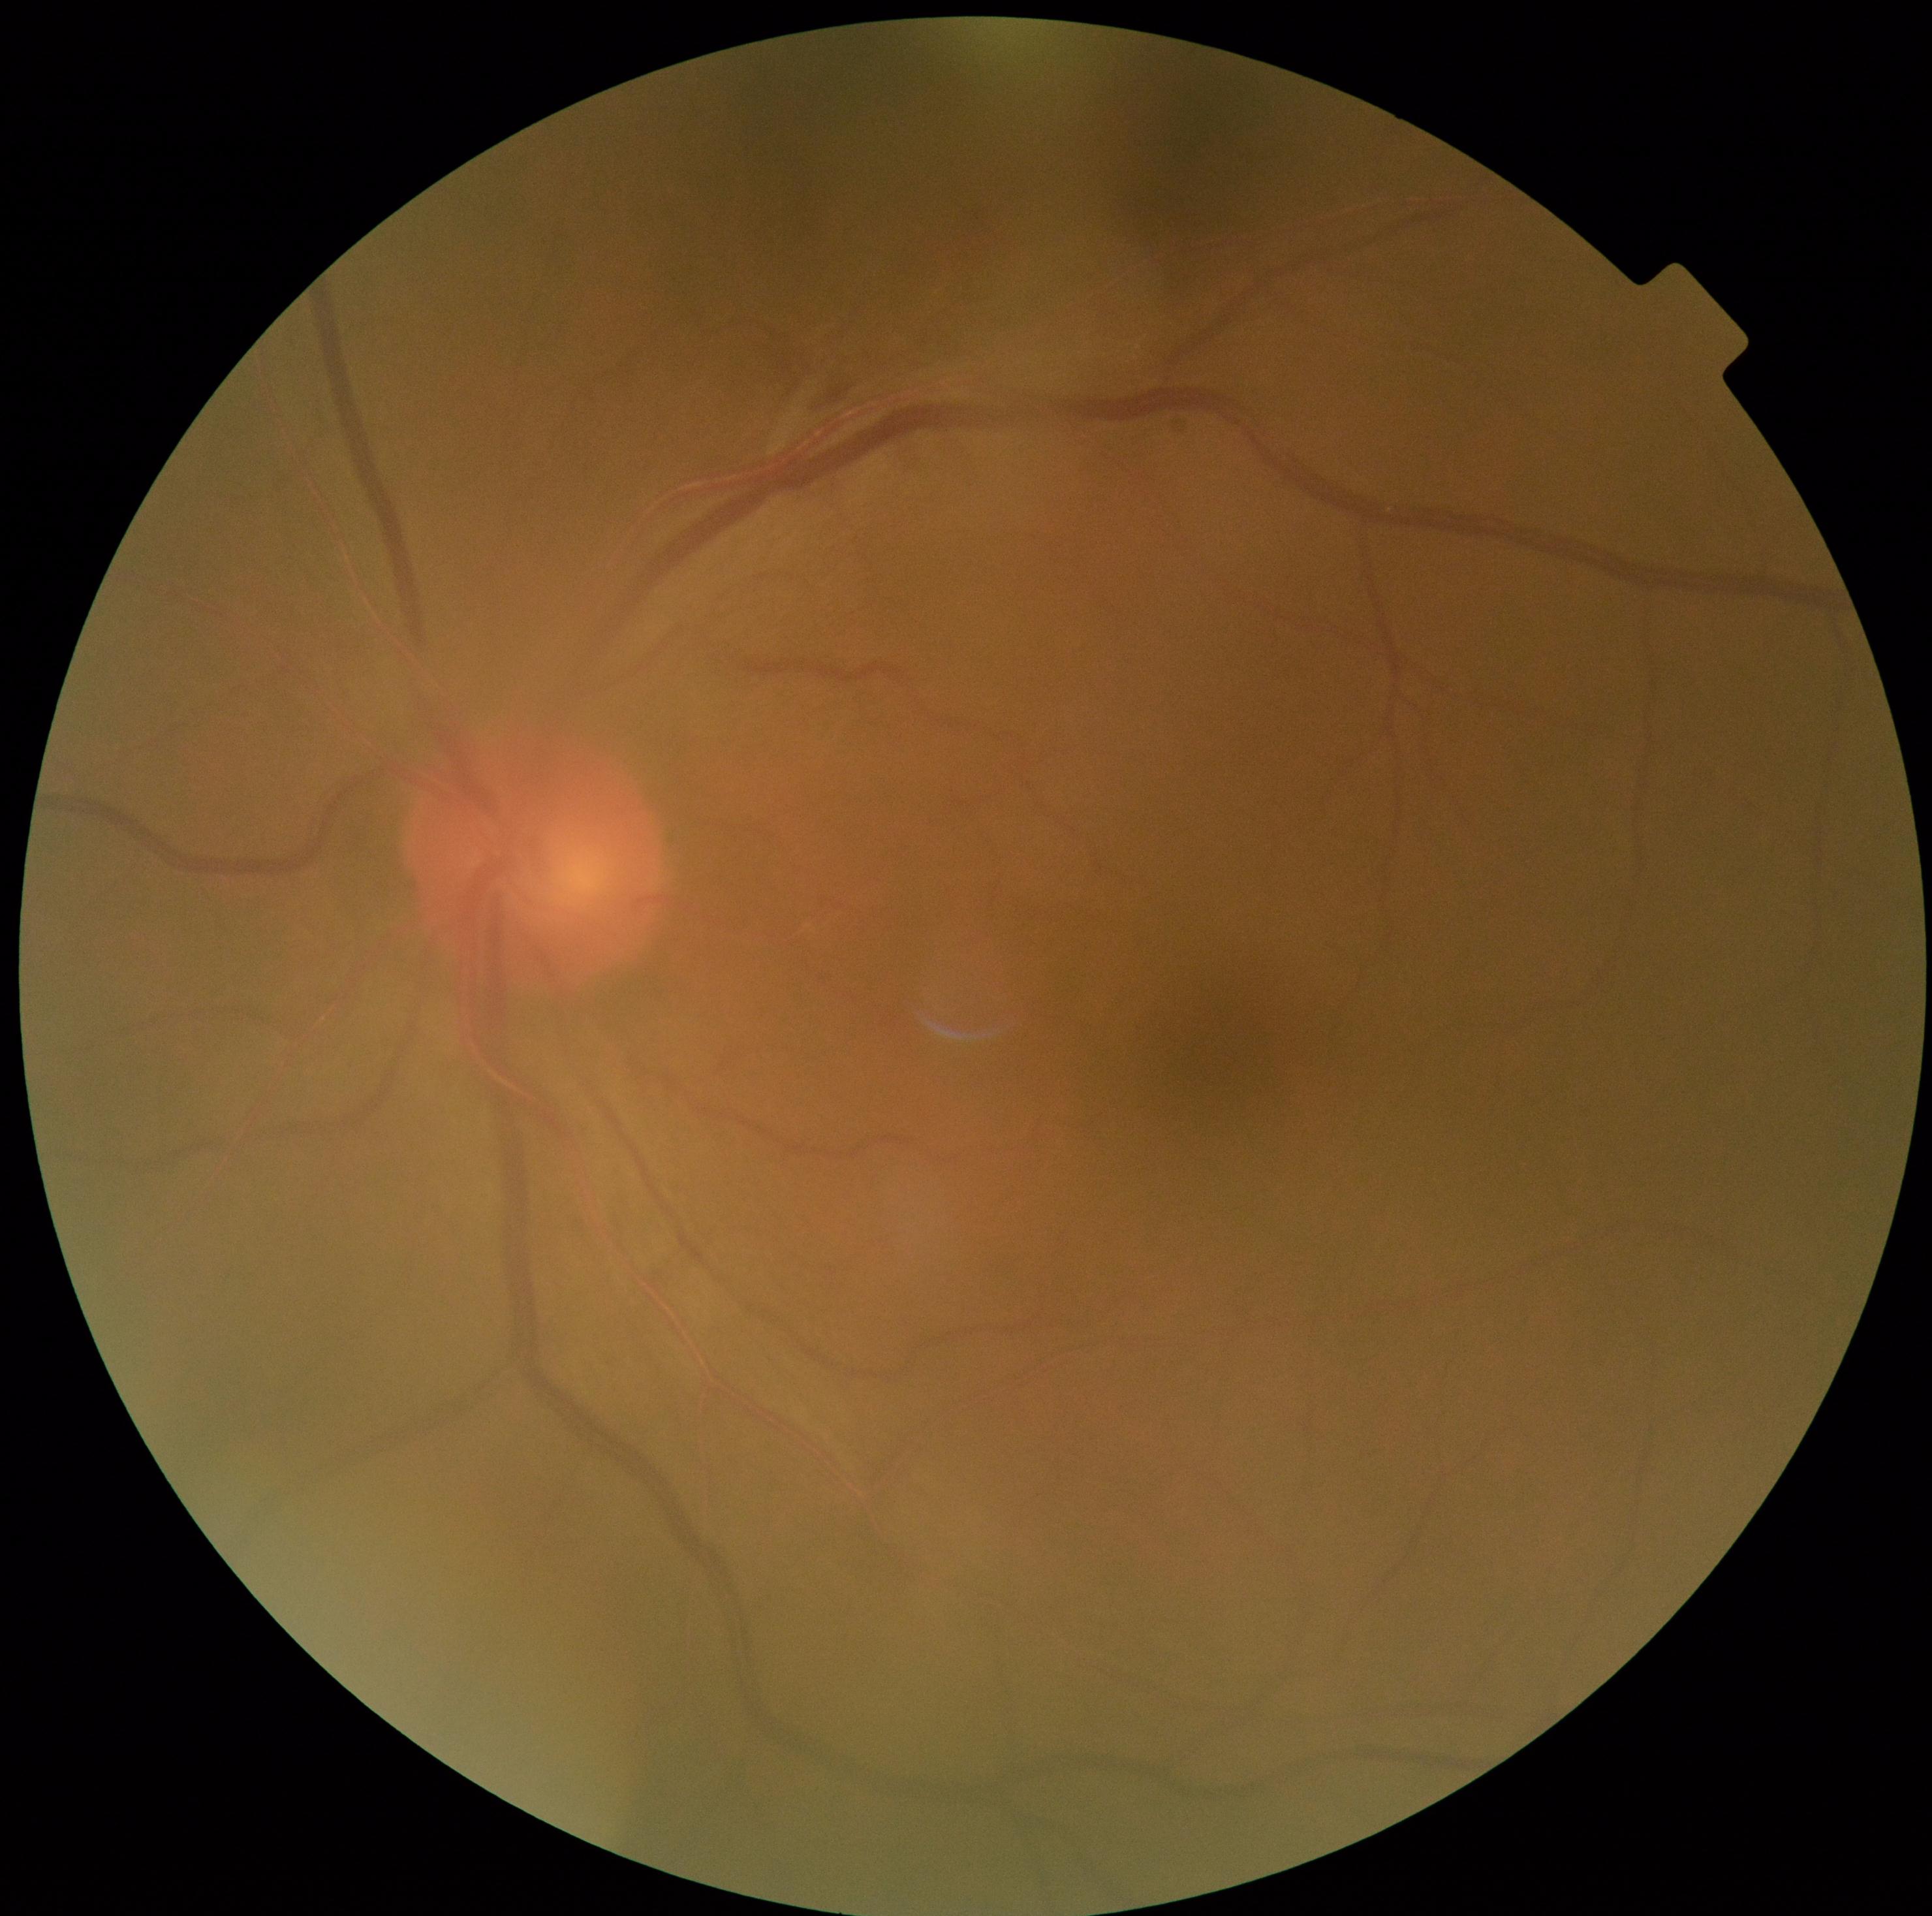

DR: moderate non-proliferative diabetic retinopathy (grade 2).